RetCam wide-field infant fundus image — 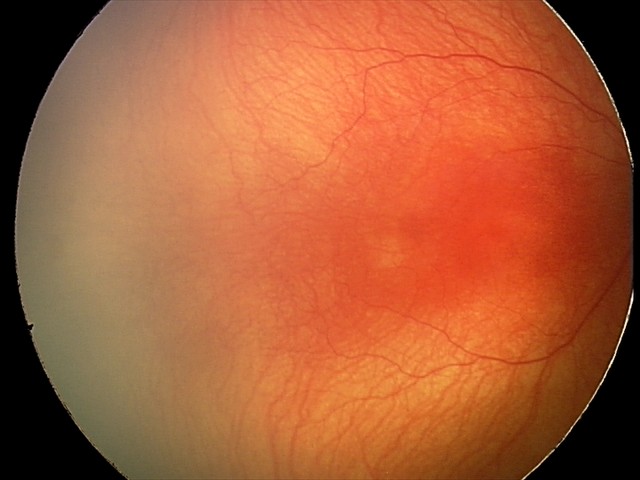

From an examination with diagnosis of aggressive retinopathy of prematurity — rapidly progressive severe ROP with prominent plus disease, often without classic stage progression.
Plus disease present.